Infant wide-field retinal image; captured with the Phoenix ICON (100° field of view):
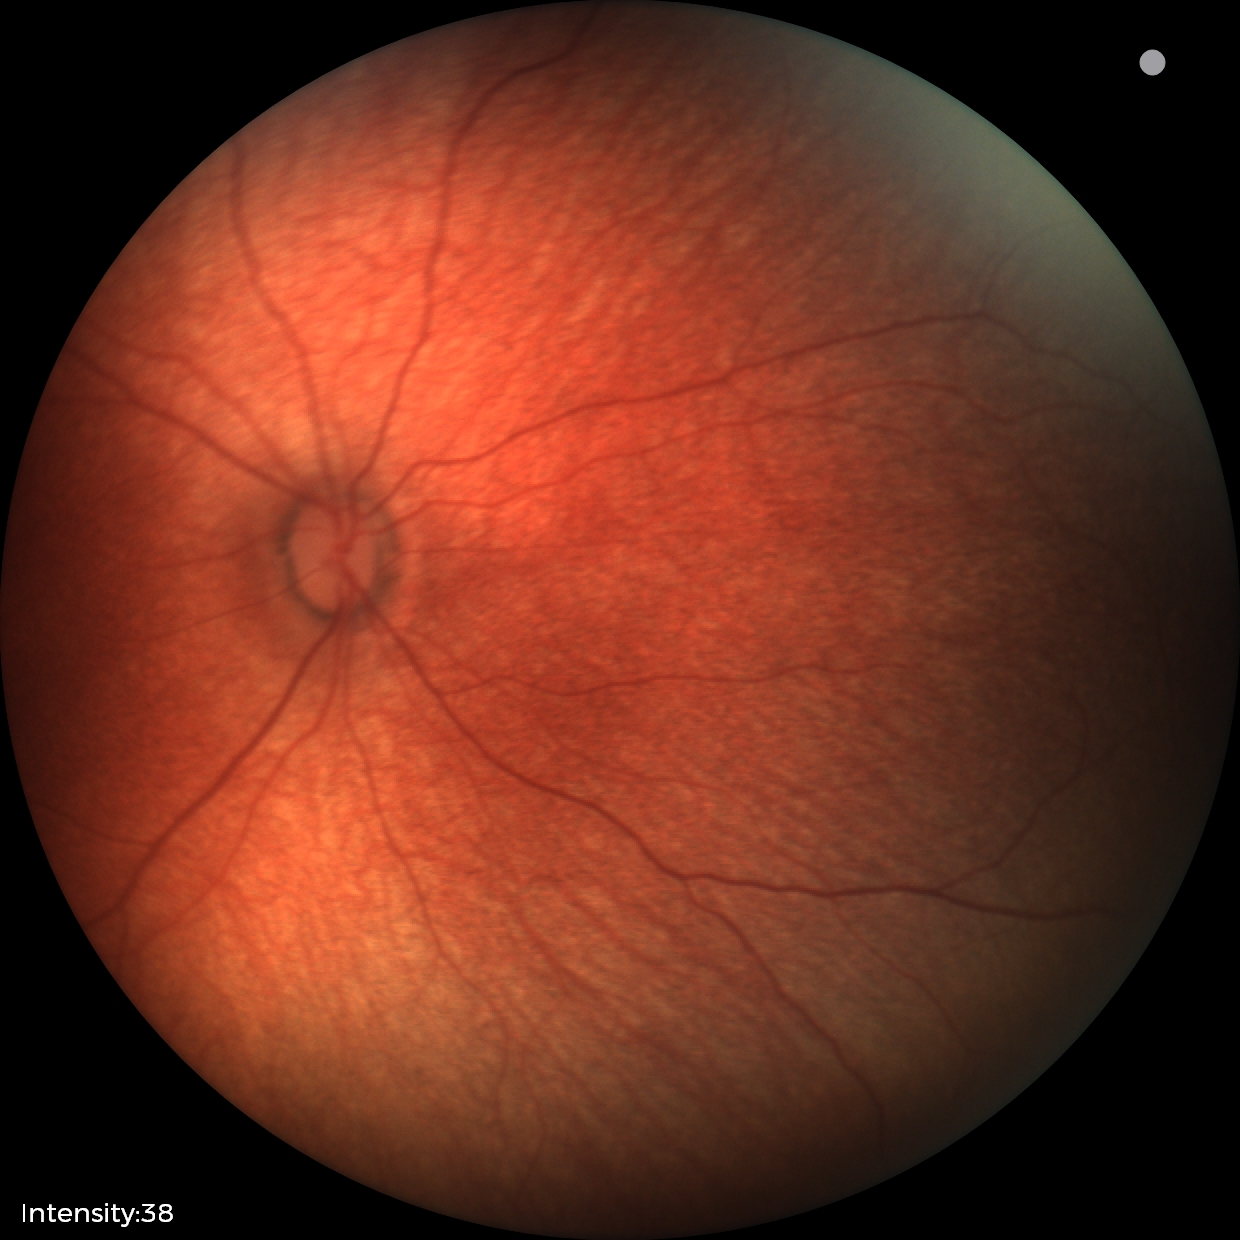 Examination with physiological retinal findings.